Color fundus image · 45° FOV — 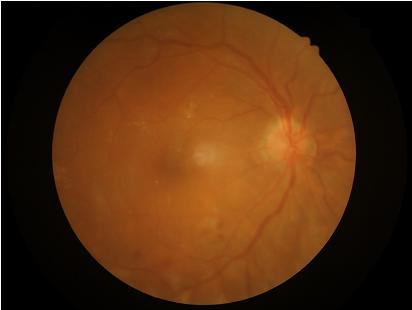

Contrast: vessels and details readily distinguishable; Clarity: noticeable blur in the optic disc, vessels, or background; Overall image quality: inadequate for clinical interpretation.